Without pupil dilation: 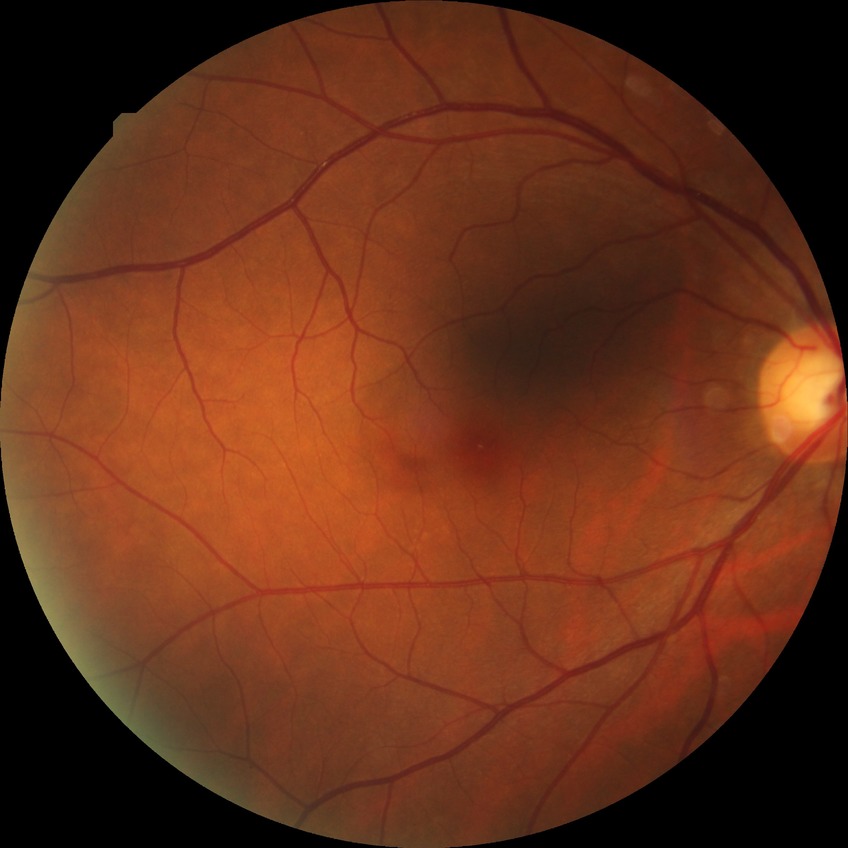
{
  "davis_grade": "no diabetic retinopathy"
}